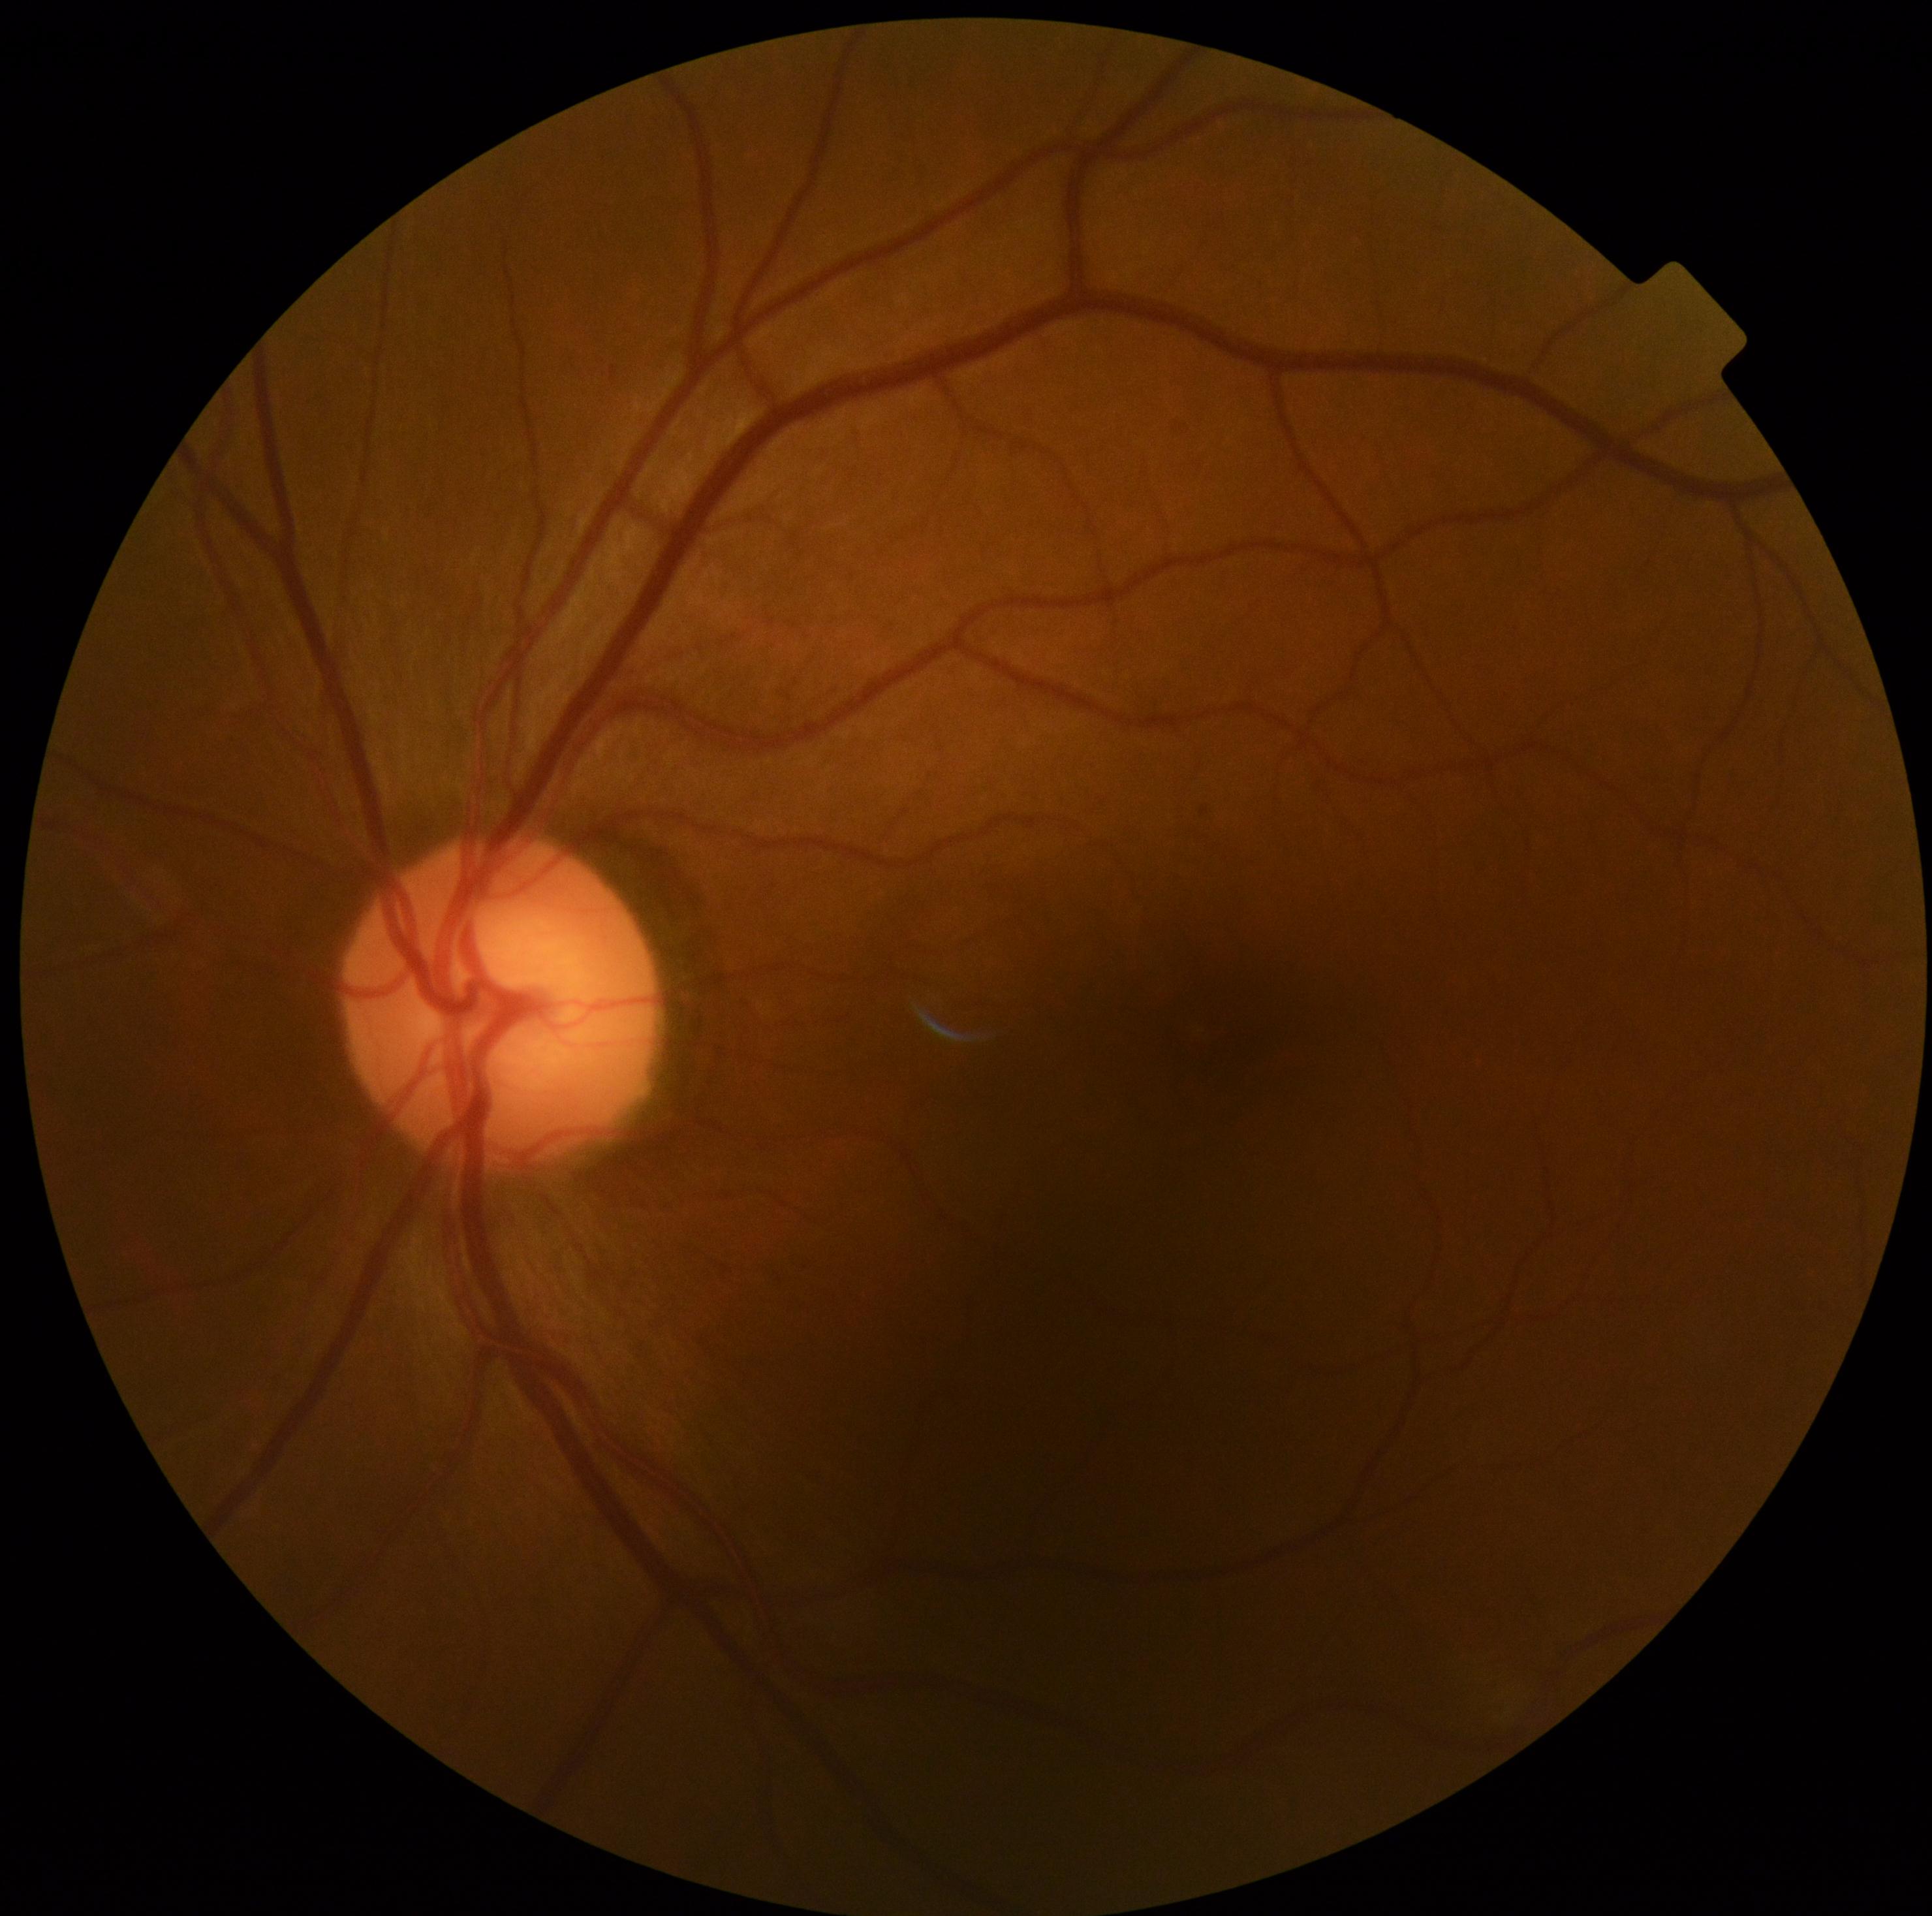

- DR stage — 0
- DR impression — no apparent DR